Nonmydriatic. Fundus photo.
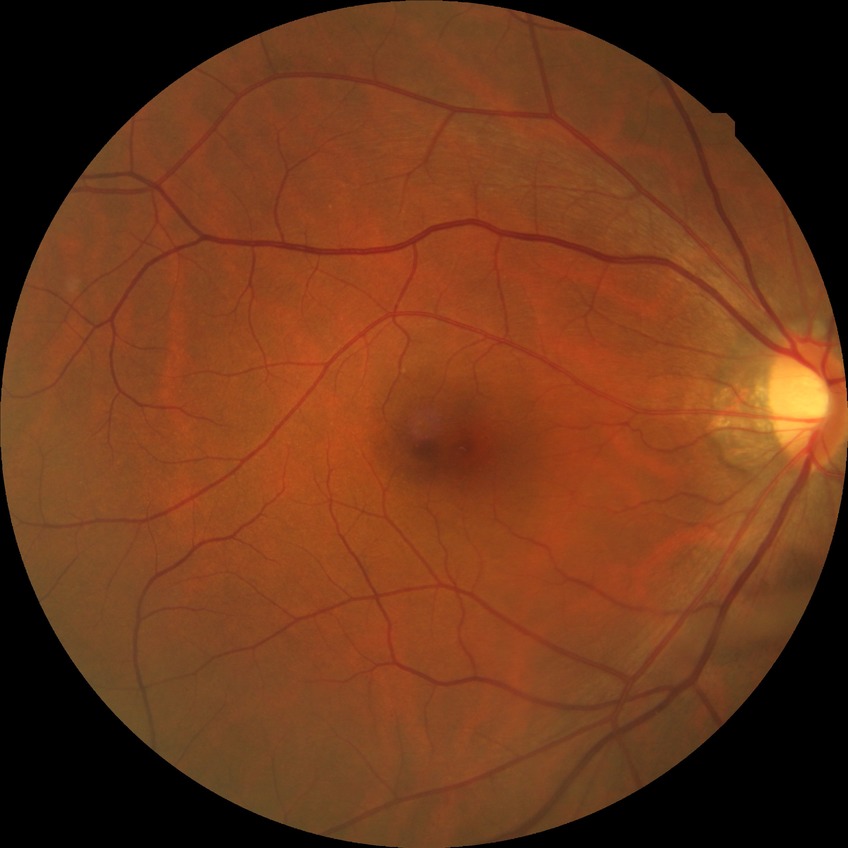 No apparent diabetic retinopathy. Davis DR grade: NDR.